Color fundus photograph.
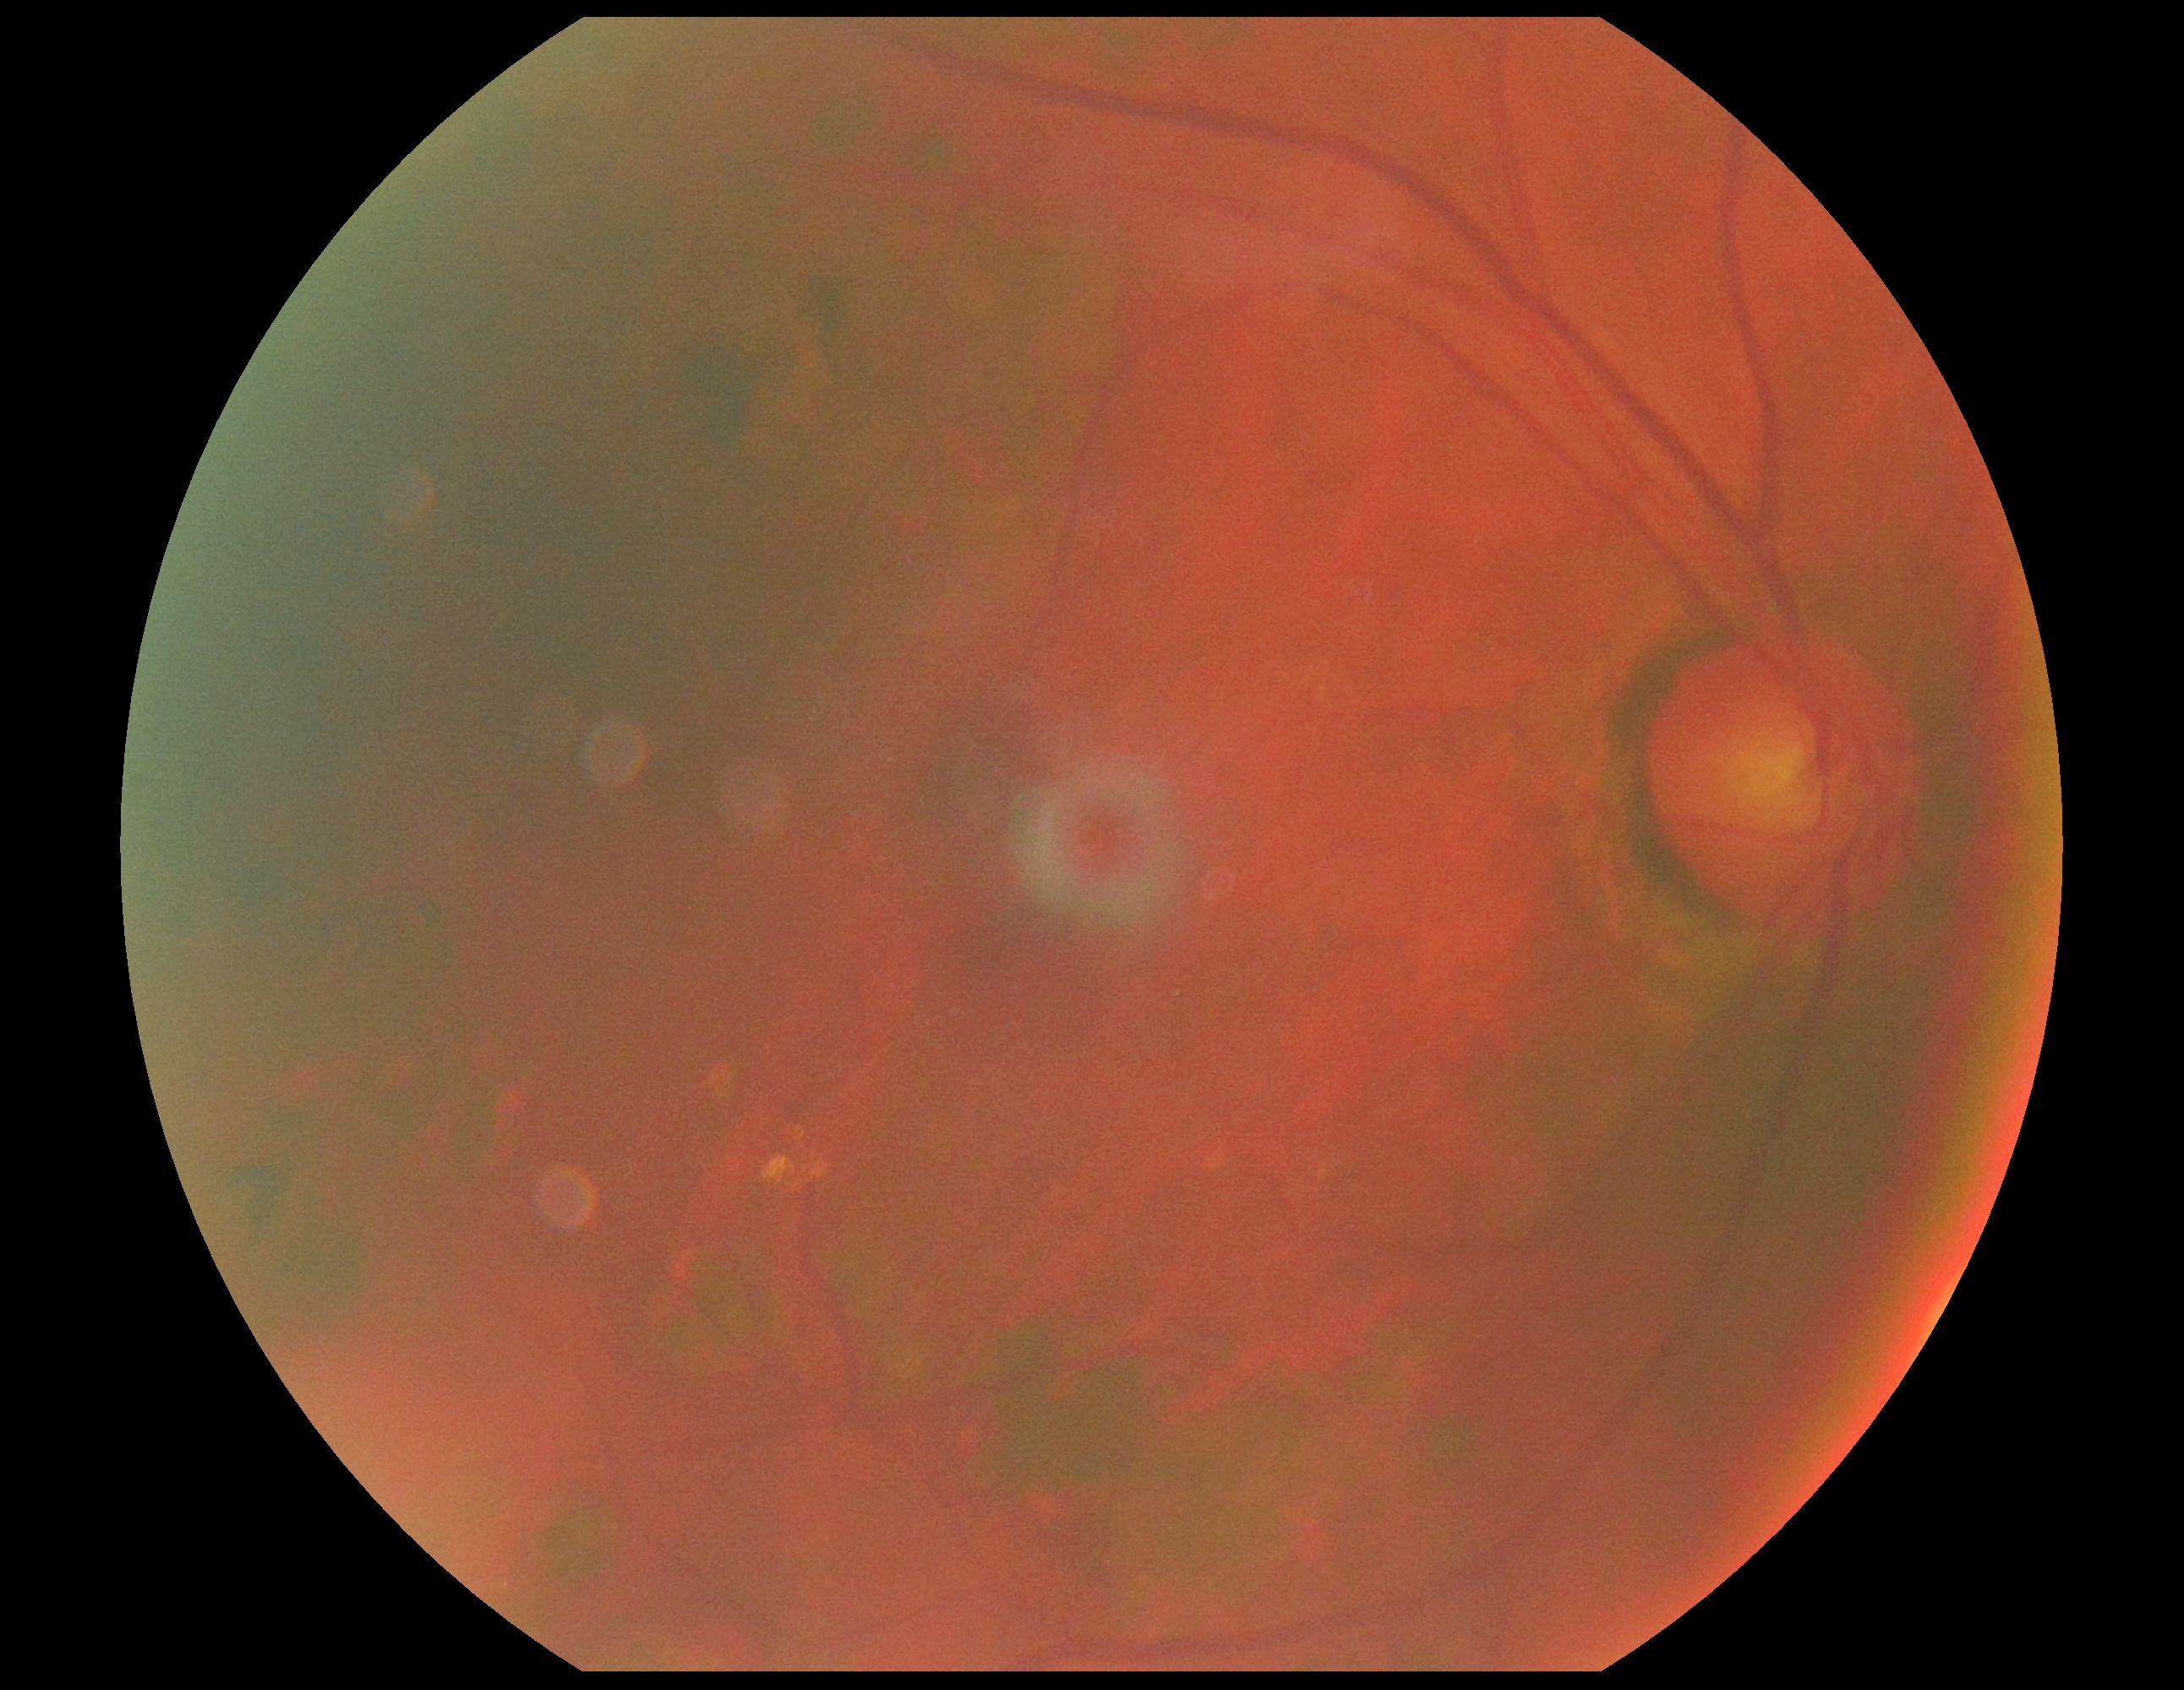
Diabetic retinopathy severity is 2/4 — more than just microaneurysms but less than severe NPDR.